CFP
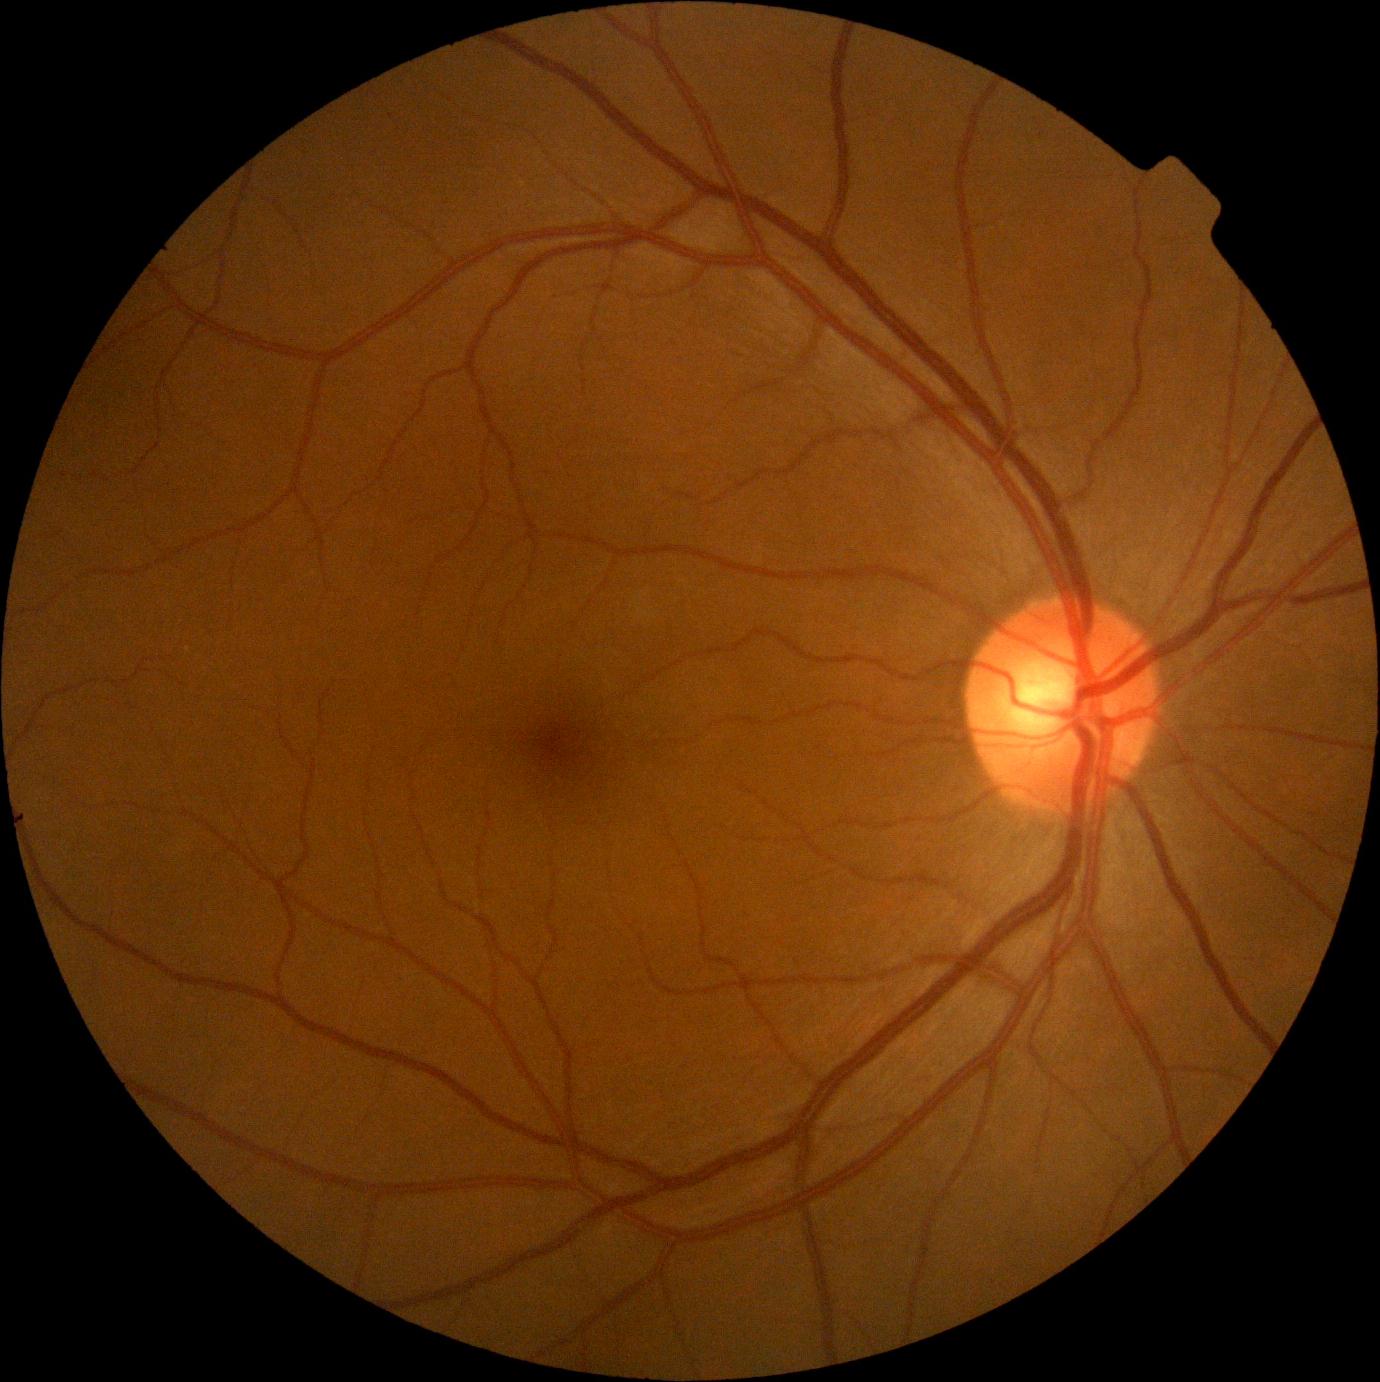

DR impression = no signs of DR, diabetic retinopathy = 0/4.